Pediatric retinal photograph (wide-field):
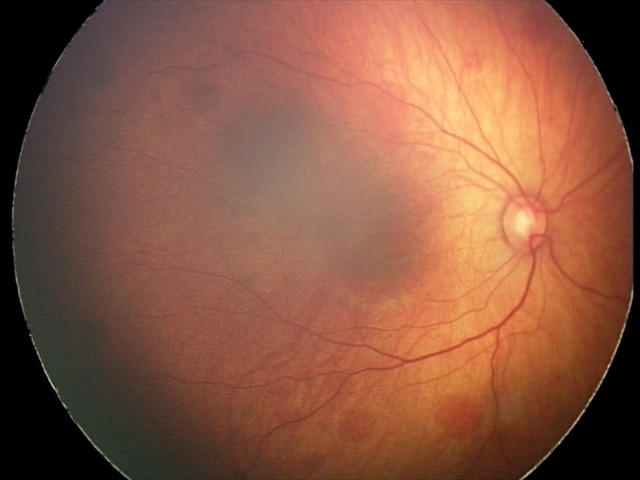

Impression: retinal hemorrhages.